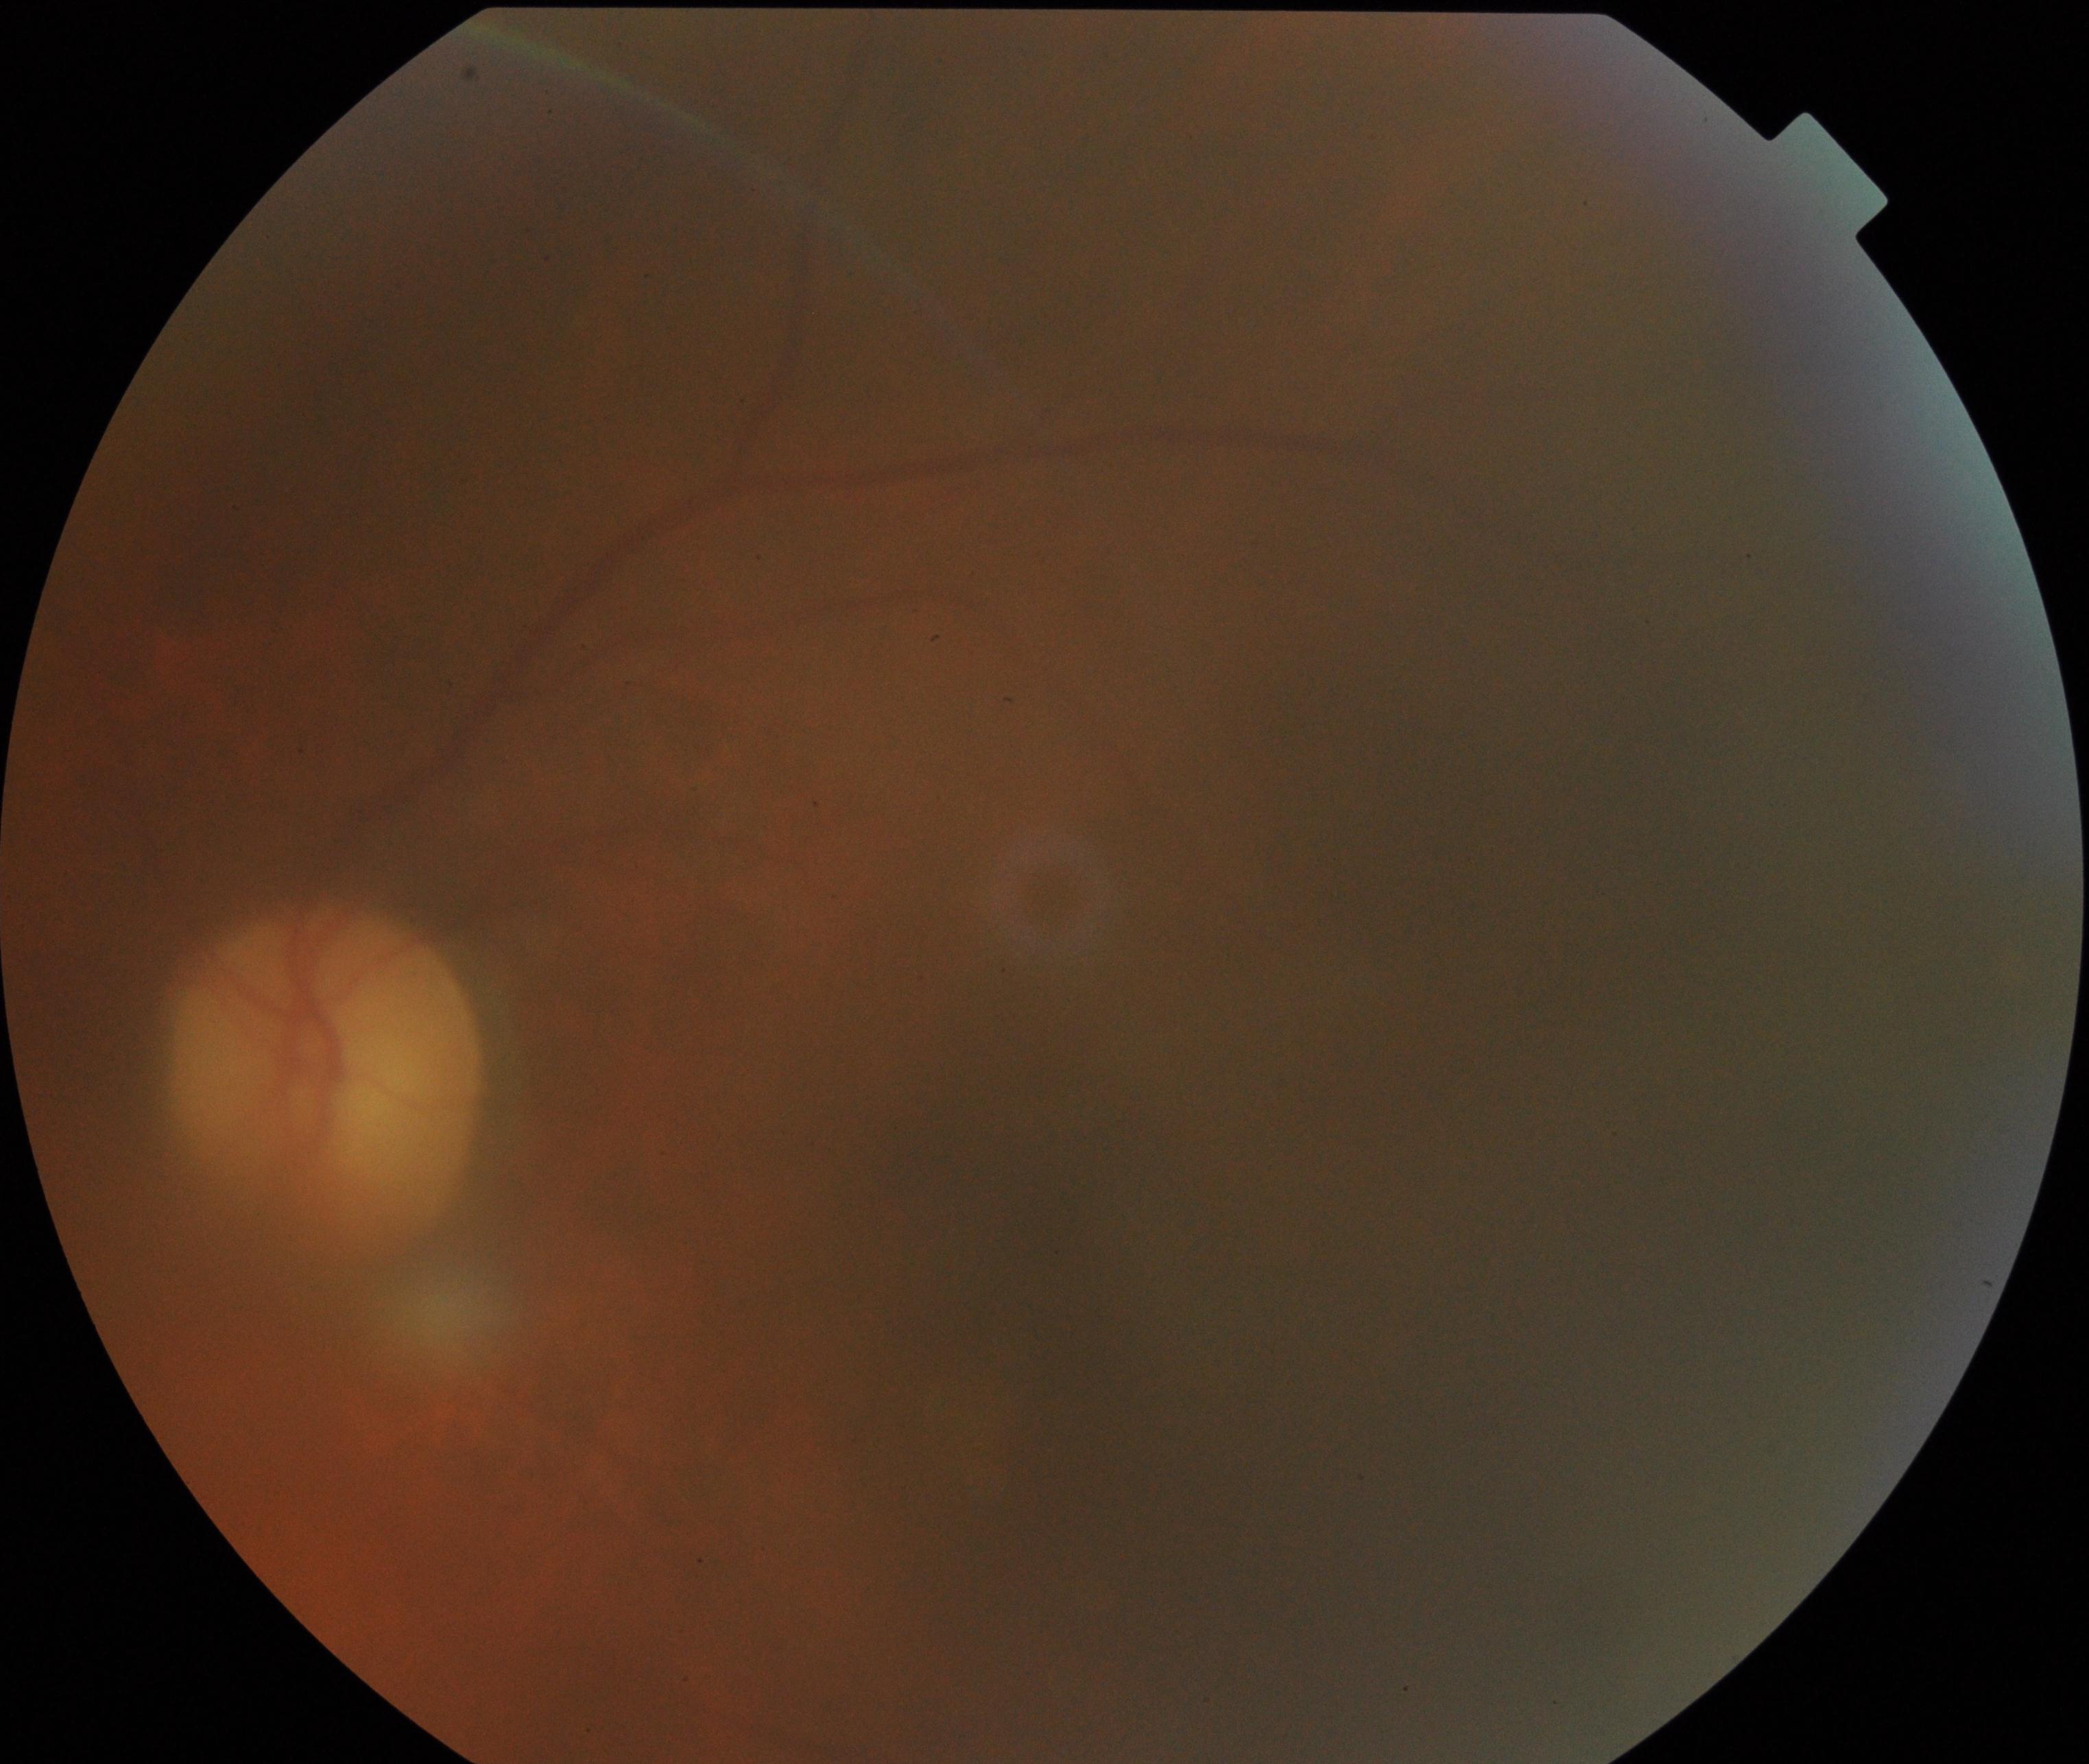

Gradability: blurred, more than half the field obscured.
Proliferative diabetic retinopathy: not identified.